Disc-centered fundus crop: 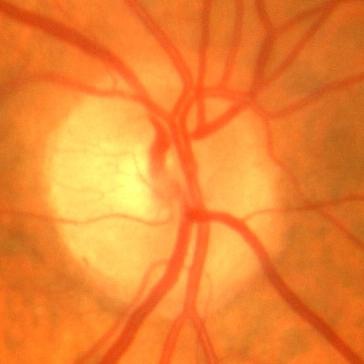

No glaucomatous optic neuropathy.